Color fundus photograph · 1659x2212 · acquired with a Remidio Fundus on Phone (FOP) camera
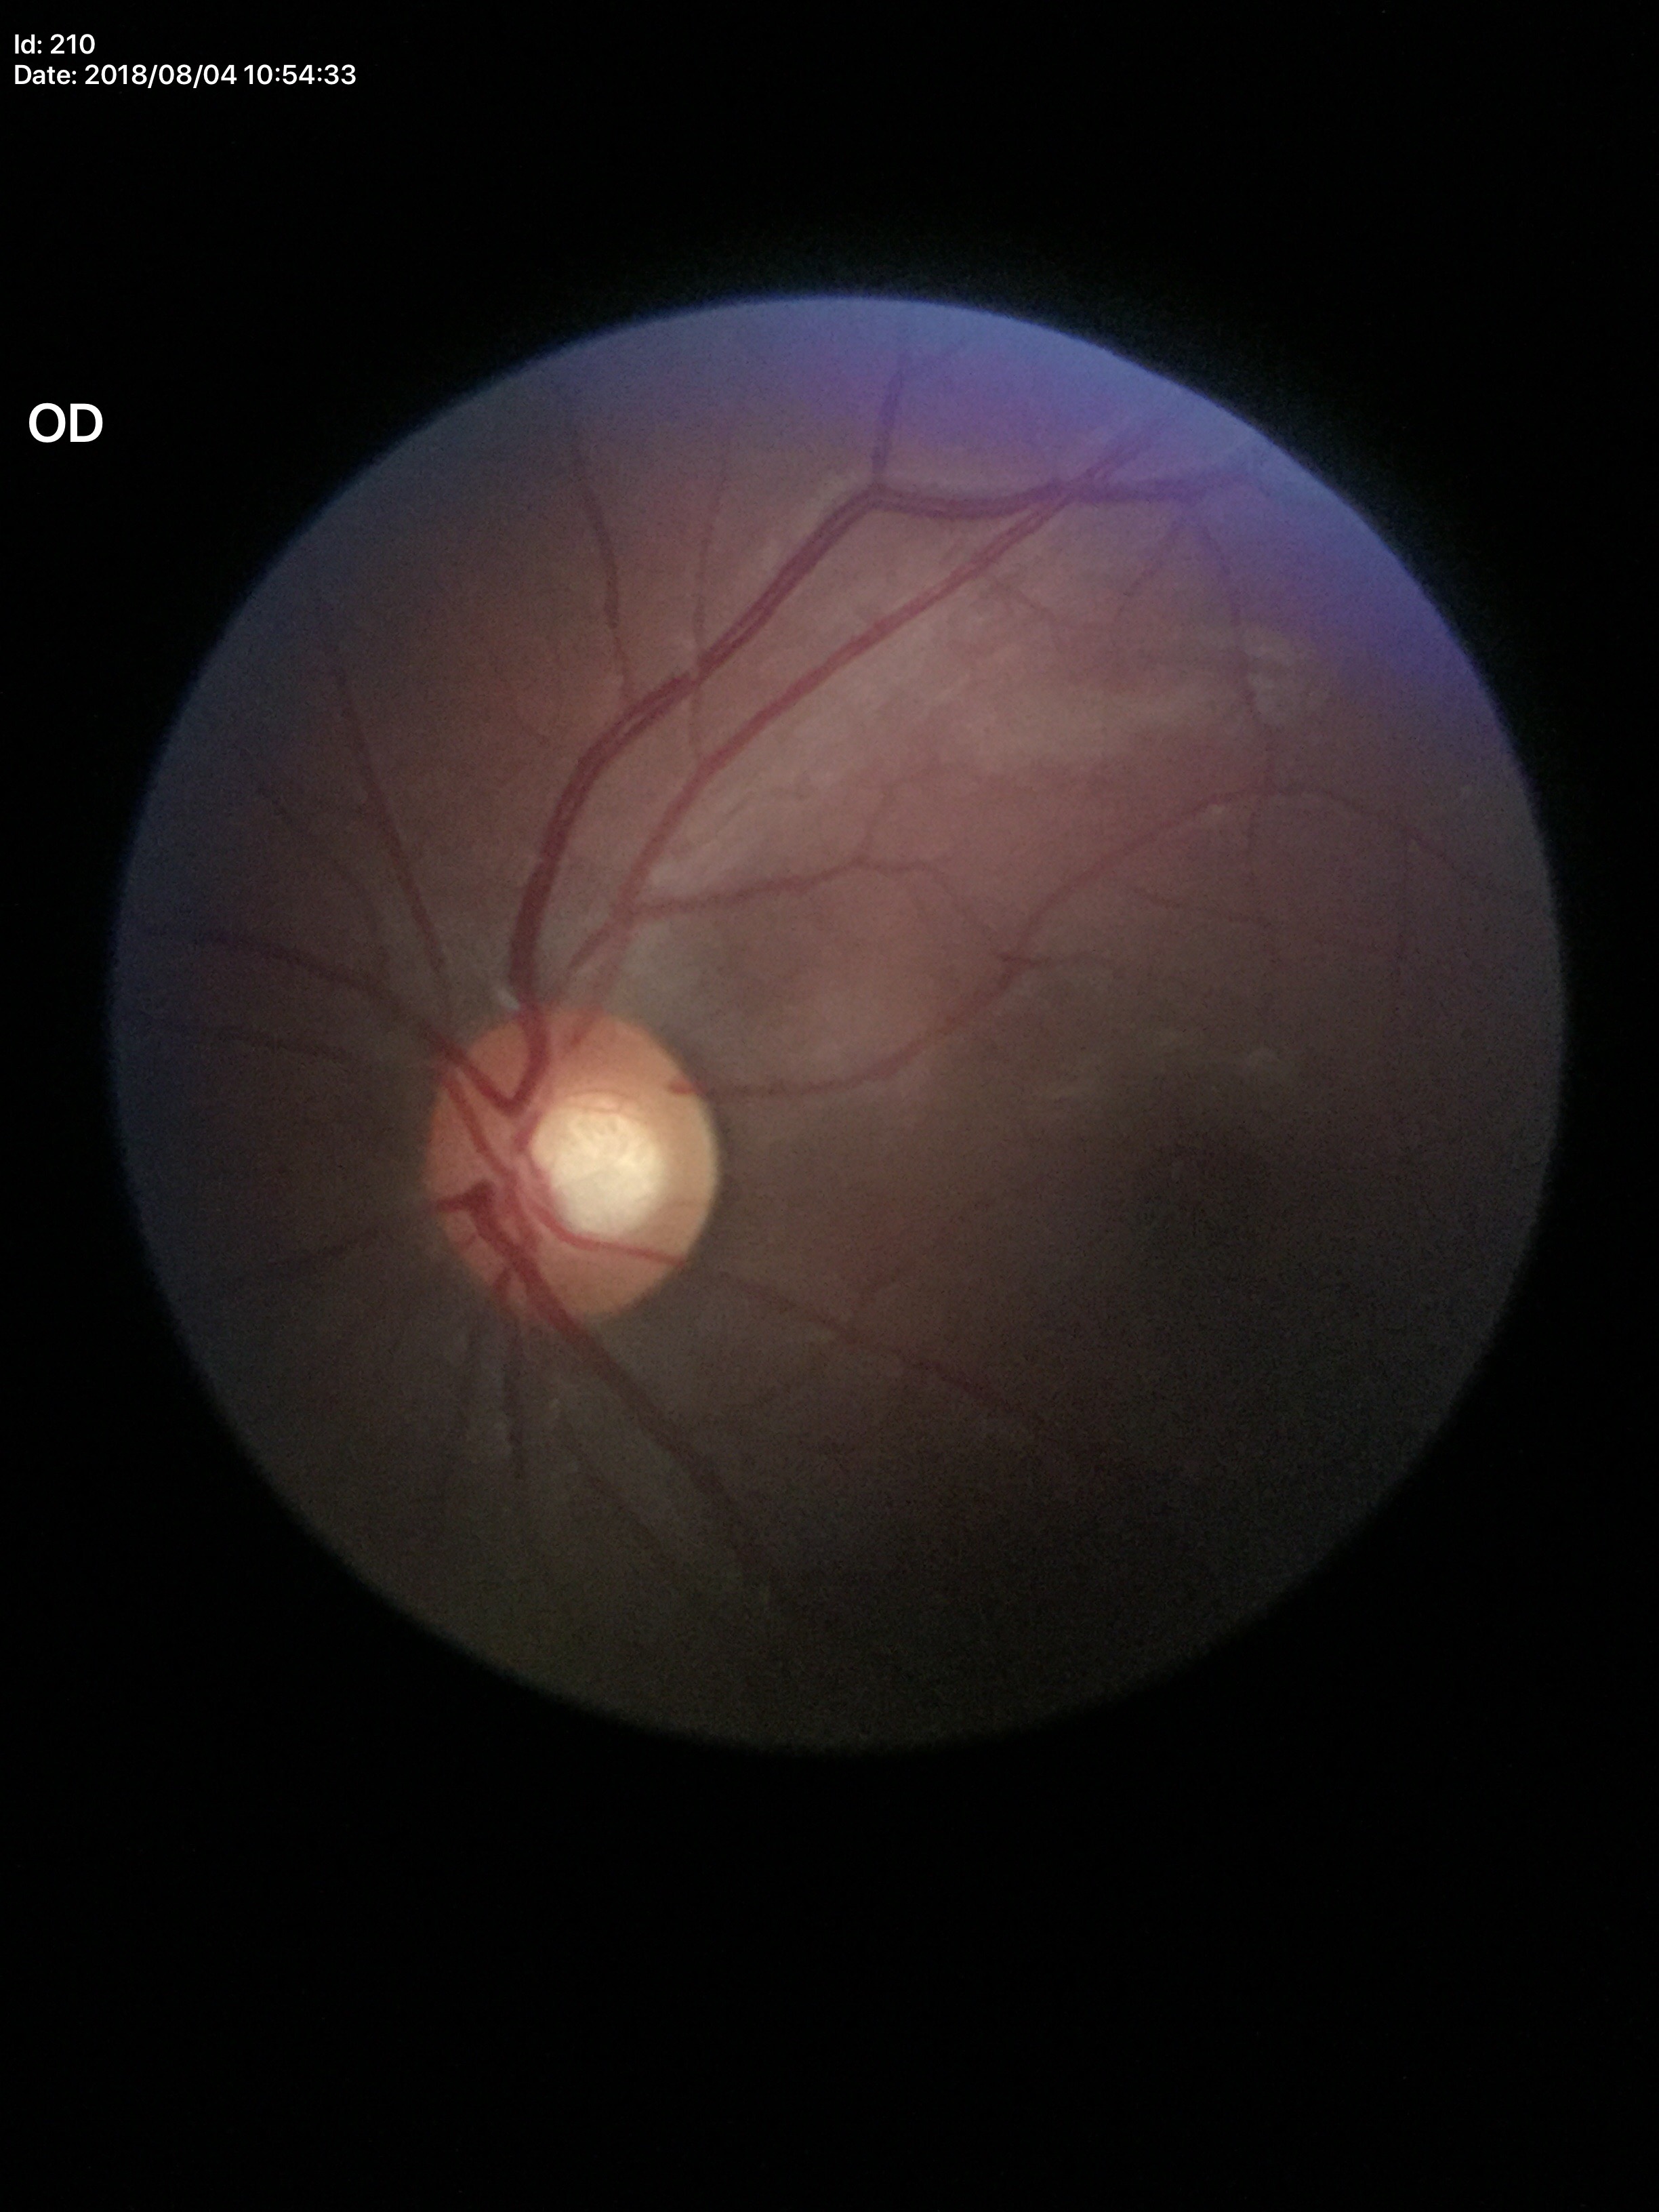
Glaucoma evaluation: negative (5/5 ophthalmologists in agreement).
Vertical cup-disc ratio is 0.56.
Horizontal CDR is 0.61.